2048x1536, color fundus photograph:
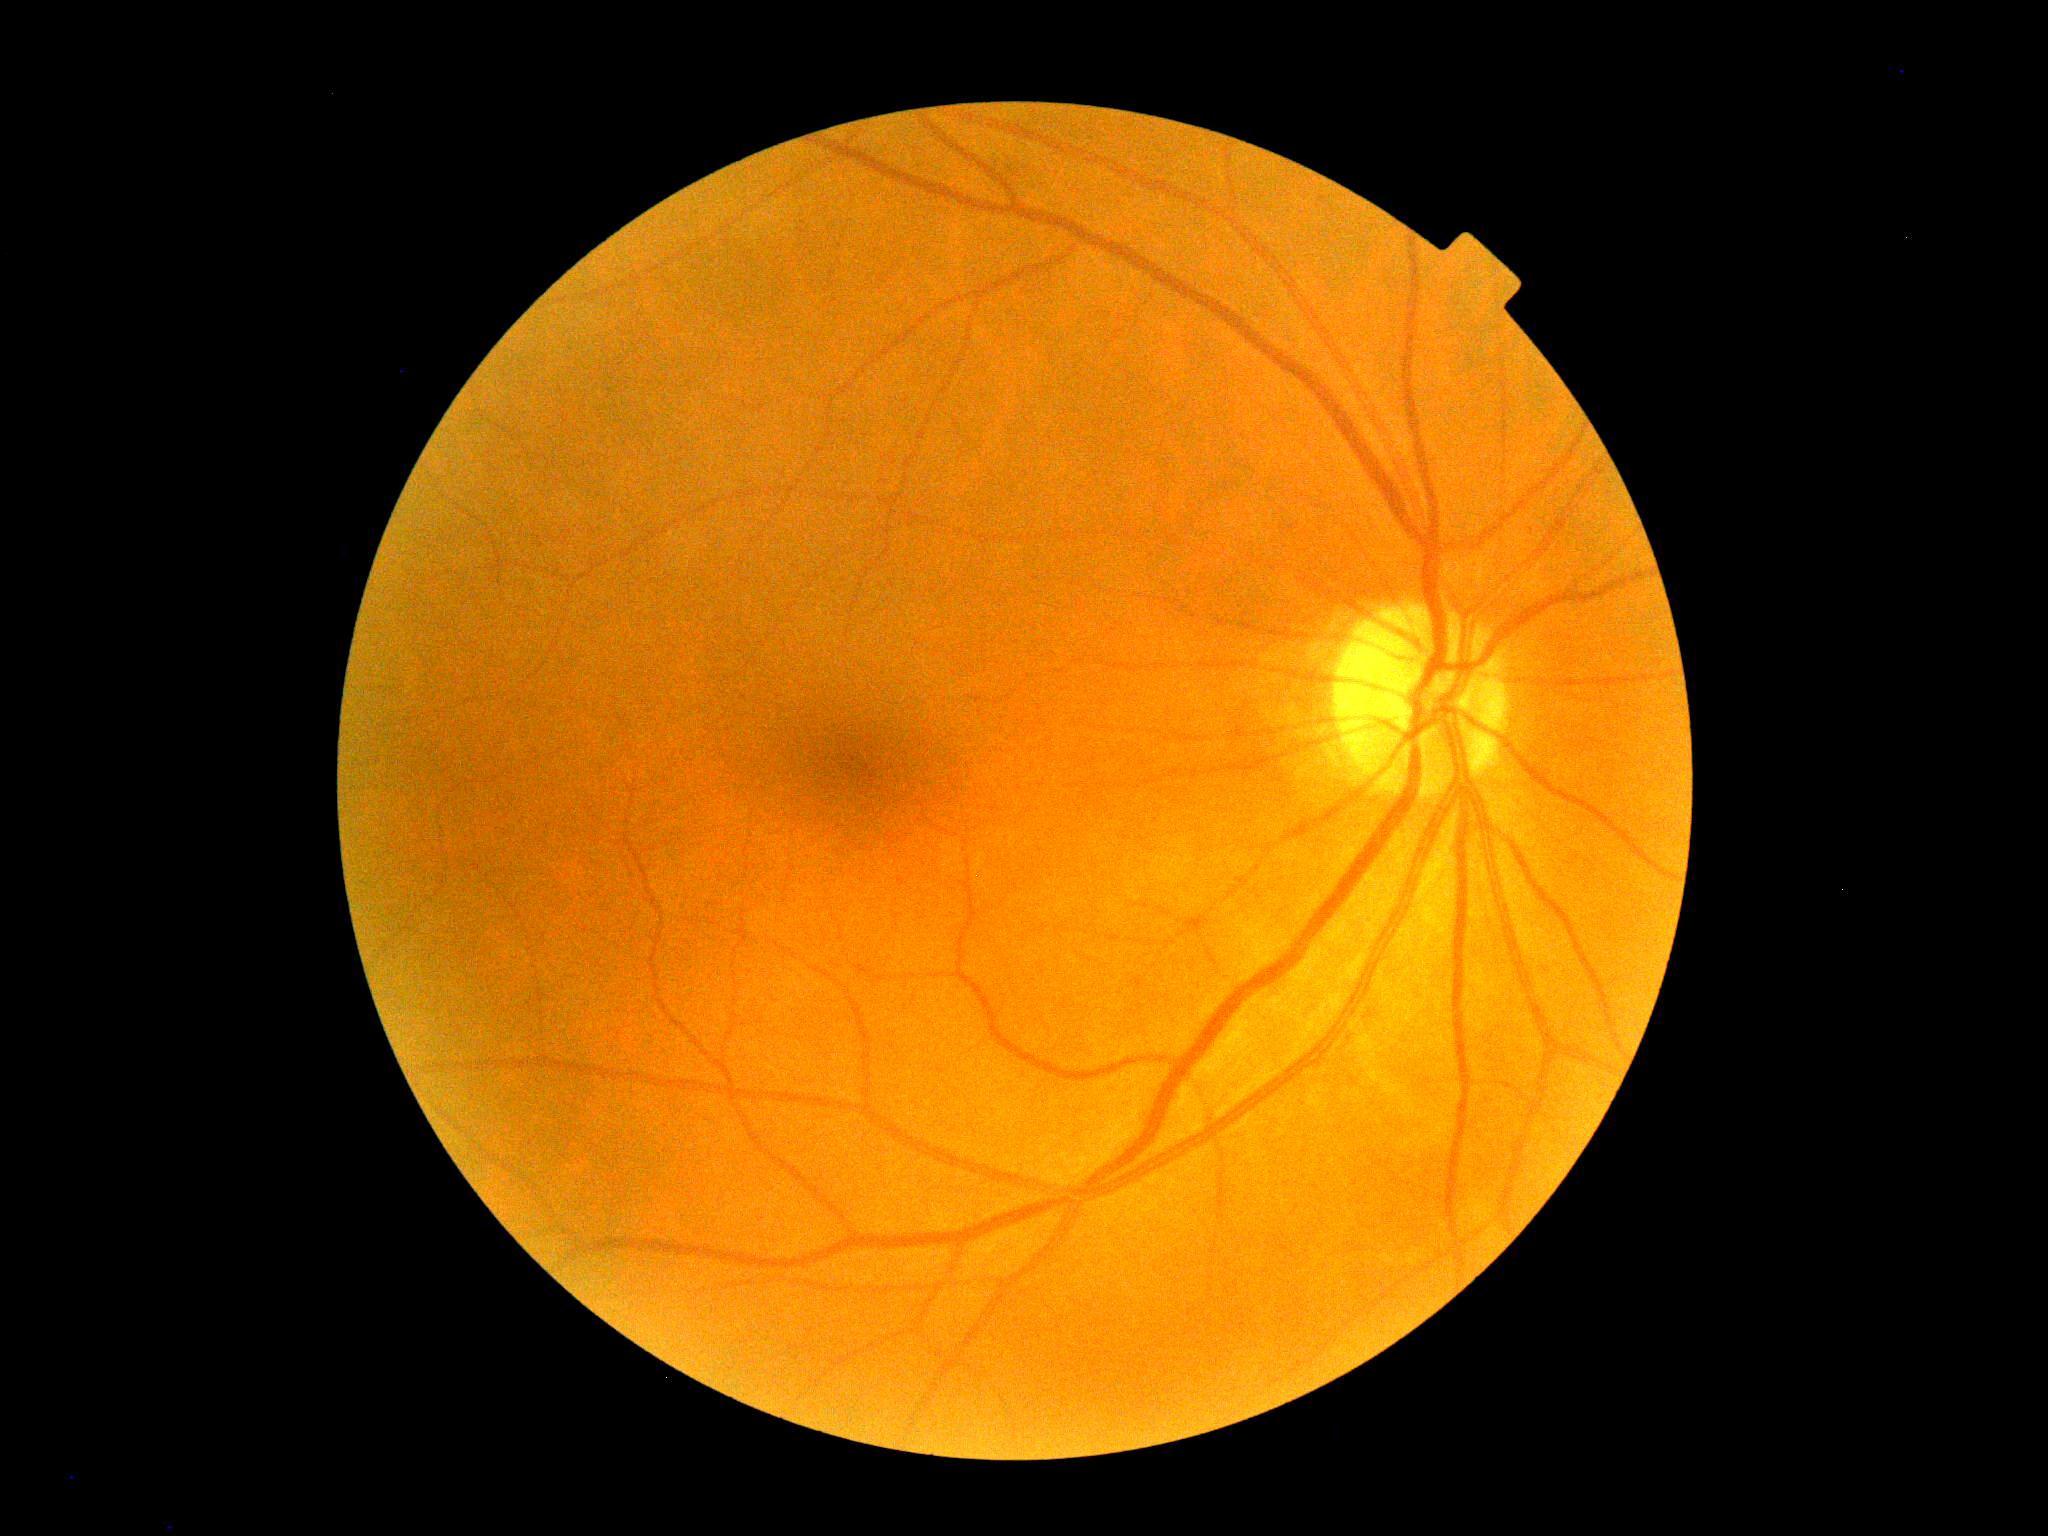 dr_grade: 0 (no apparent retinopathy)